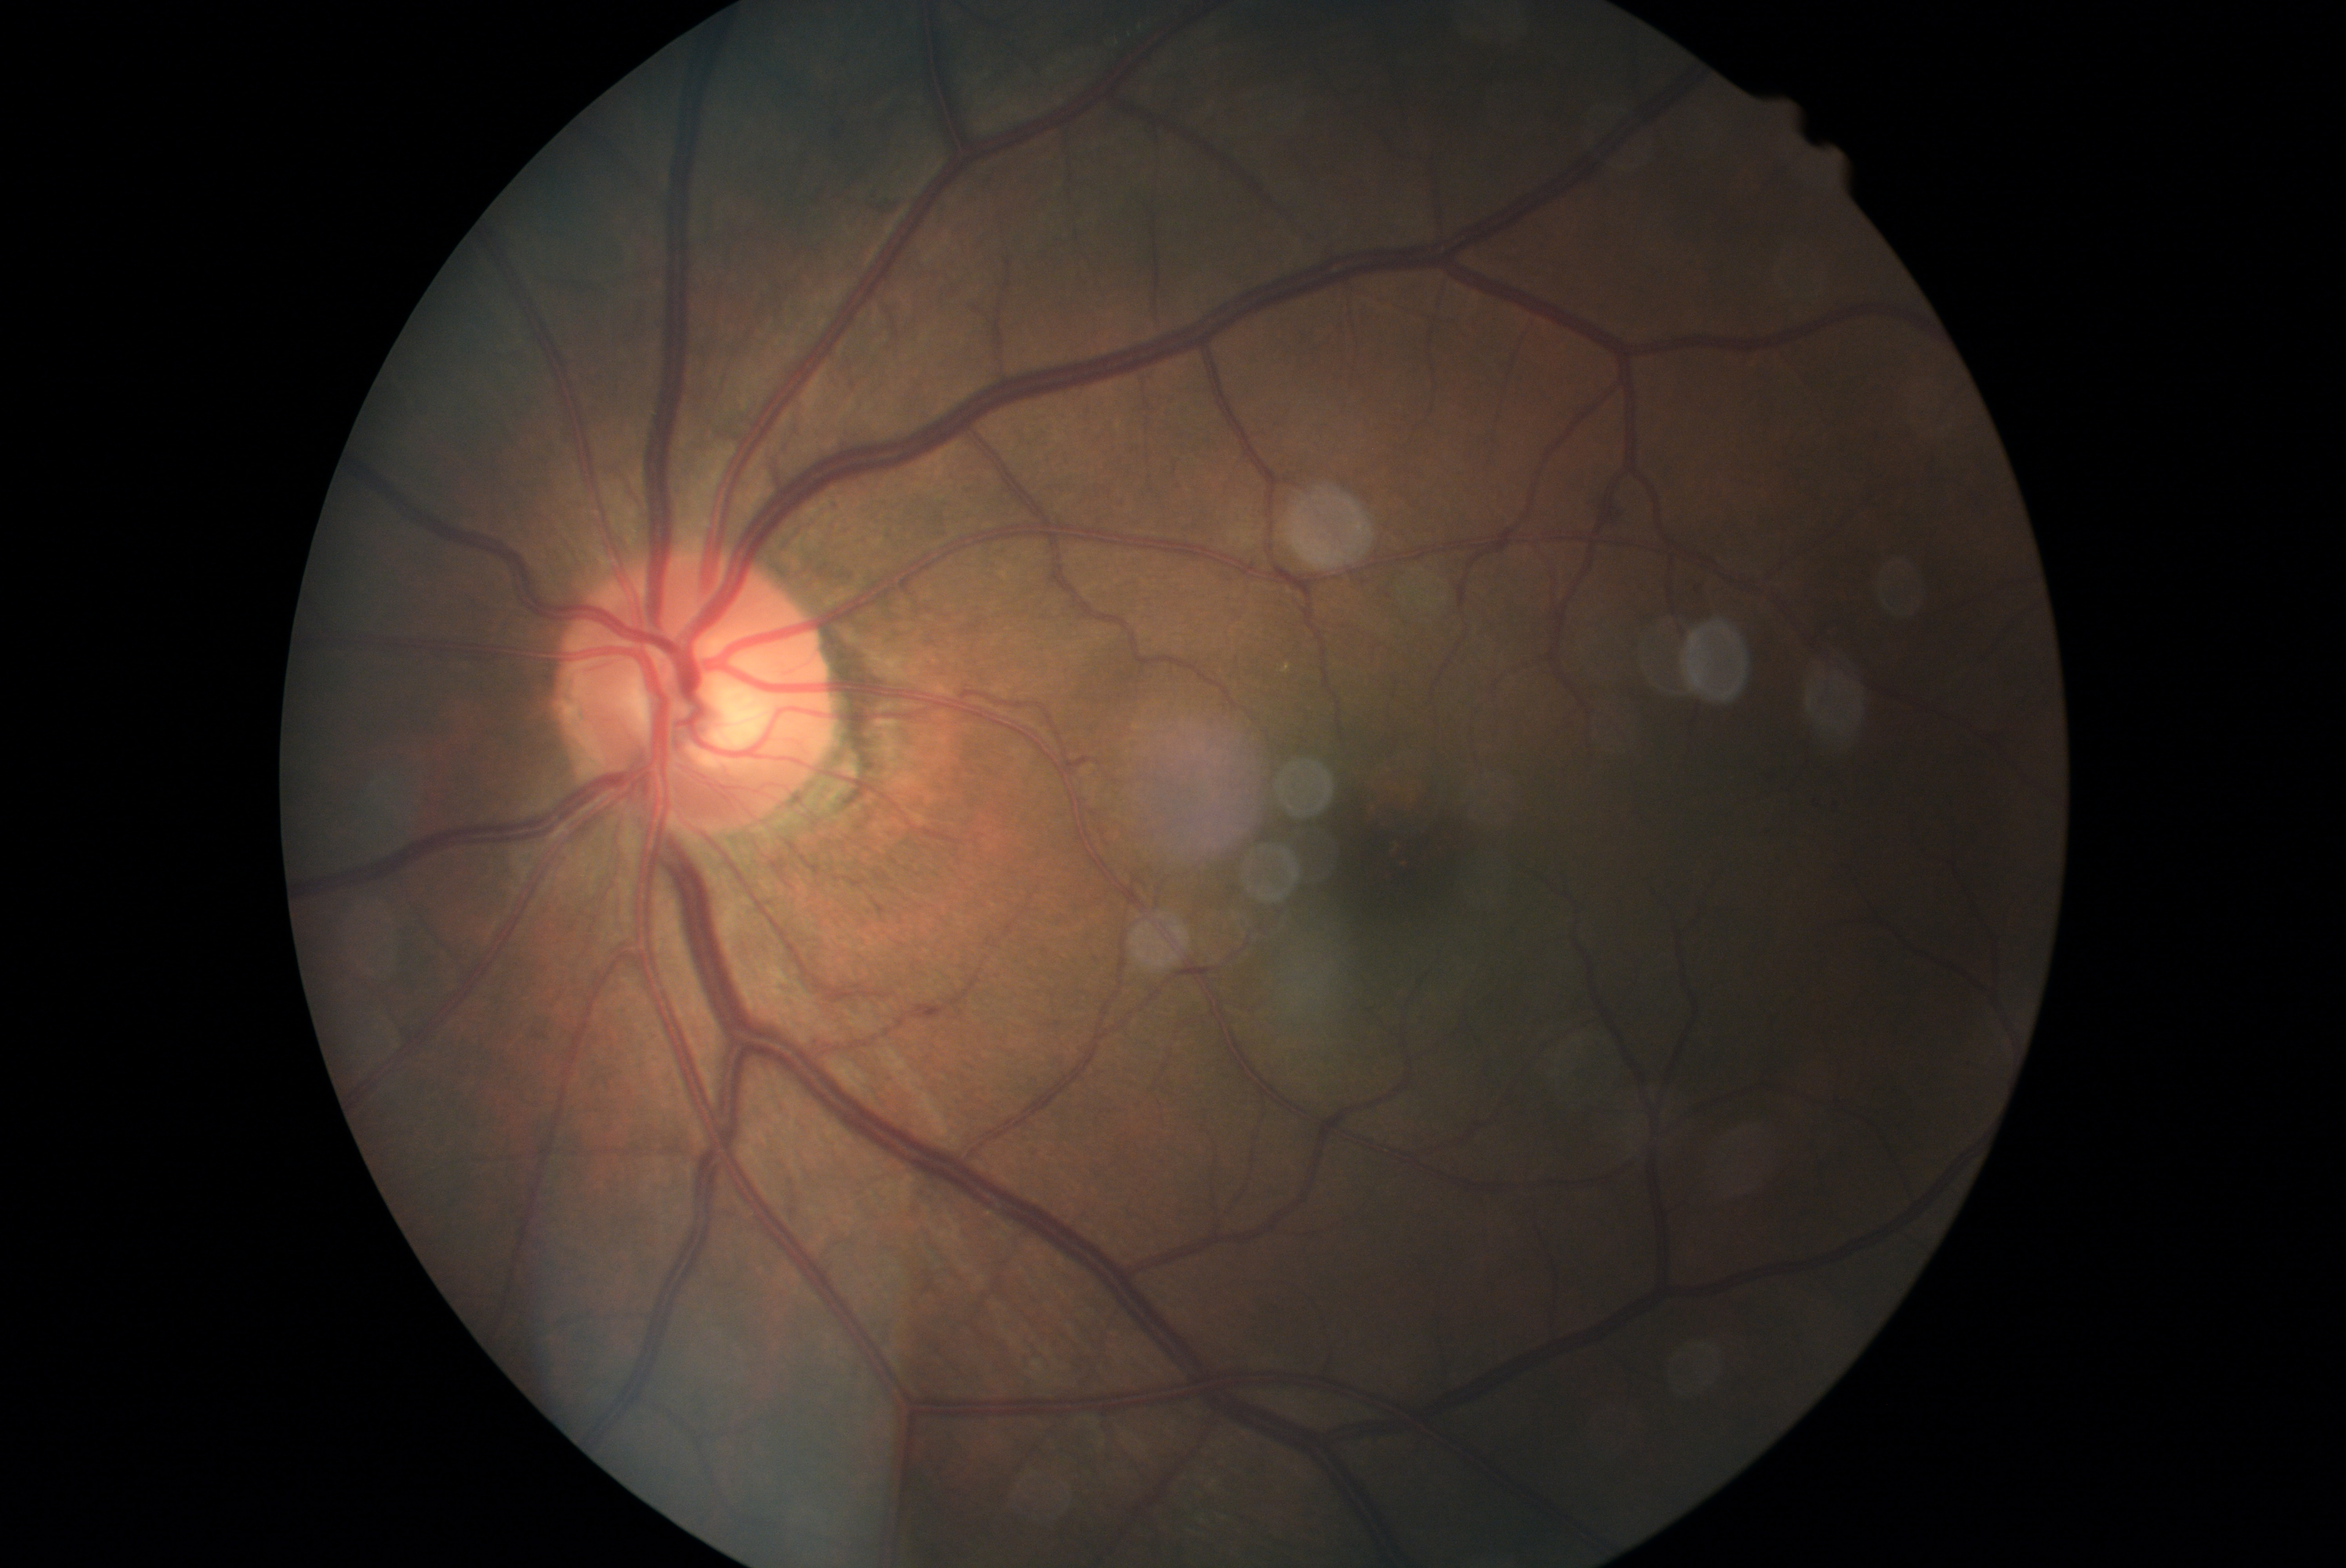 diabetic retinopathy grade = 2 (moderate NPDR)